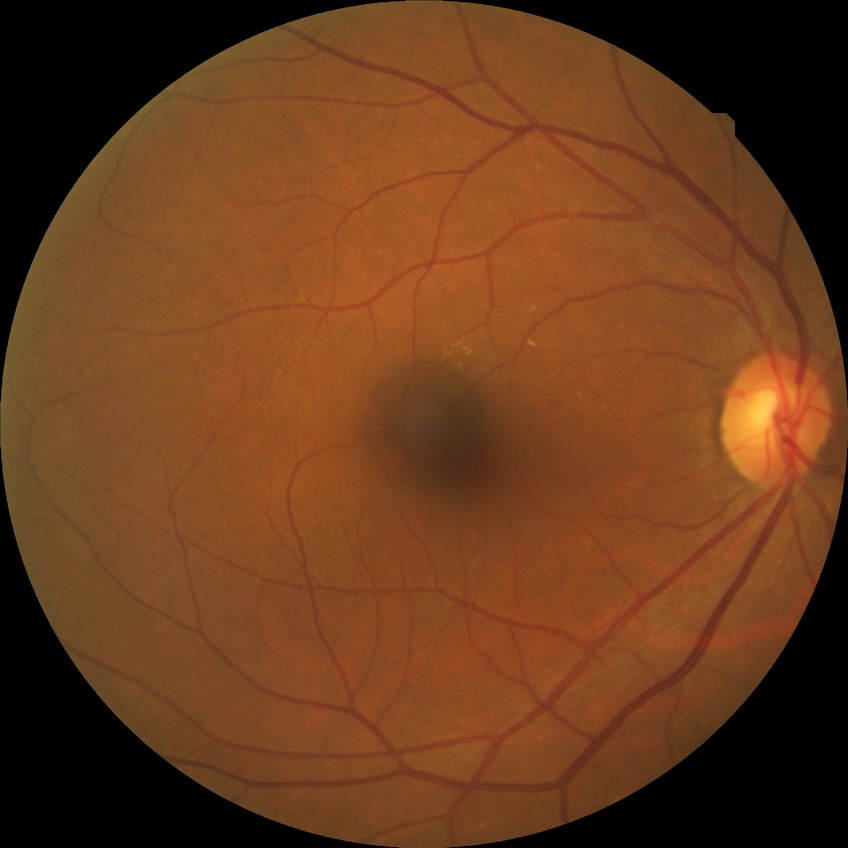

diabetic retinopathy (DR) = no diabetic retinopathy (NDR).